Optic disc photograph — 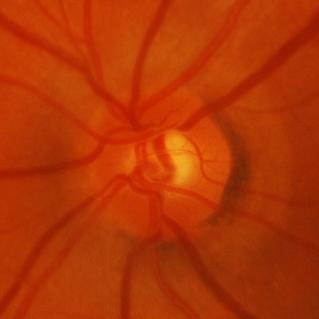

Diagnosis: glaucomatous damage to the optic nerve.